Pediatric wide-field fundus photograph. Captured with the Phoenix ICON (100° field of view) — 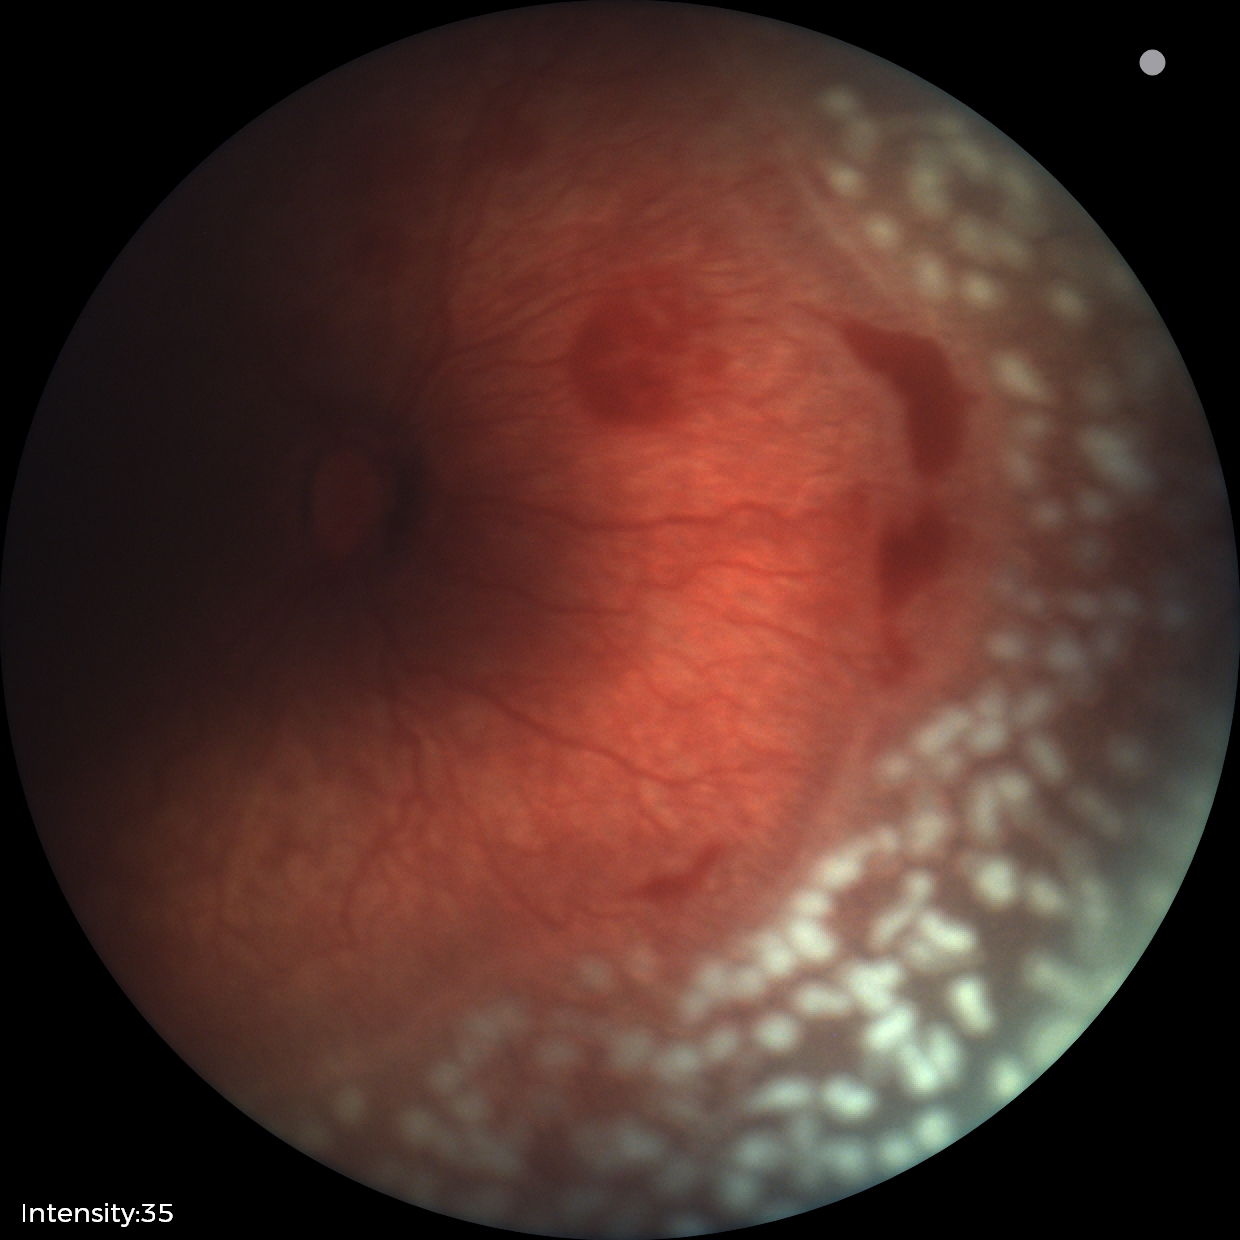
Assessment: plus disease; retinopathy of prematurity stage 2.